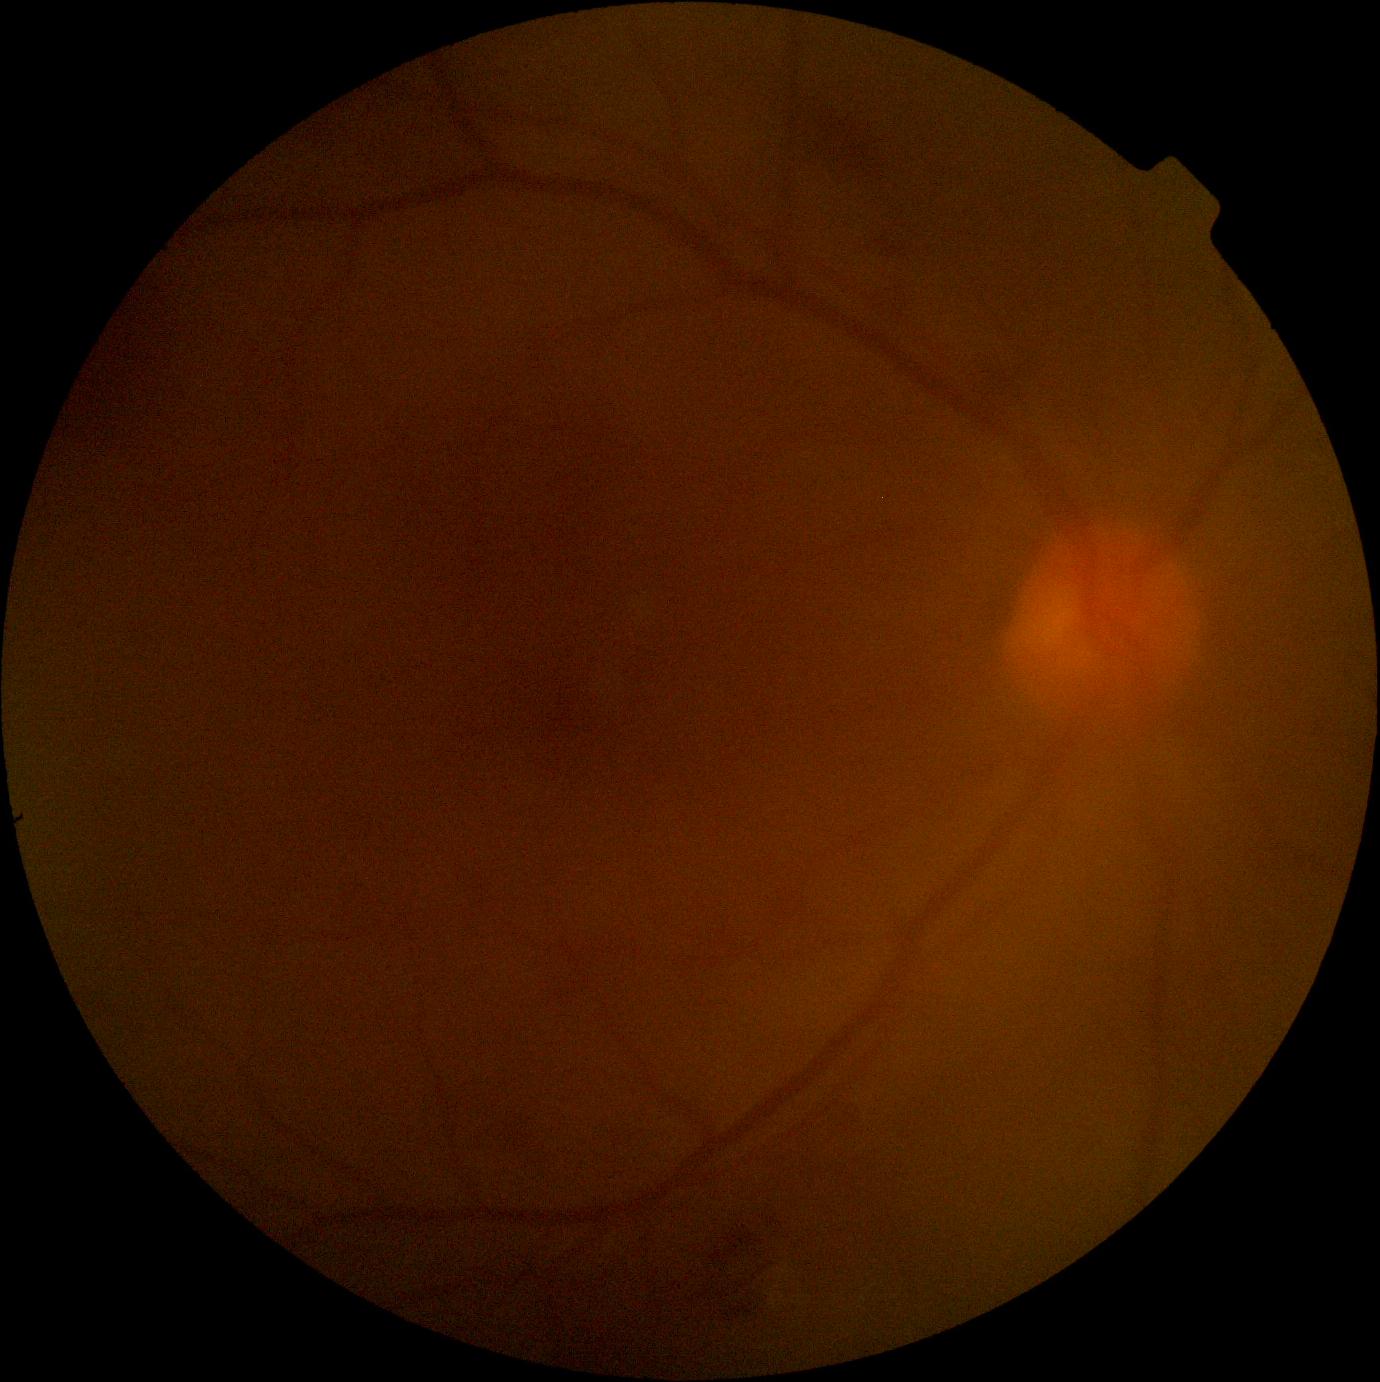

DR severity: grade 2.